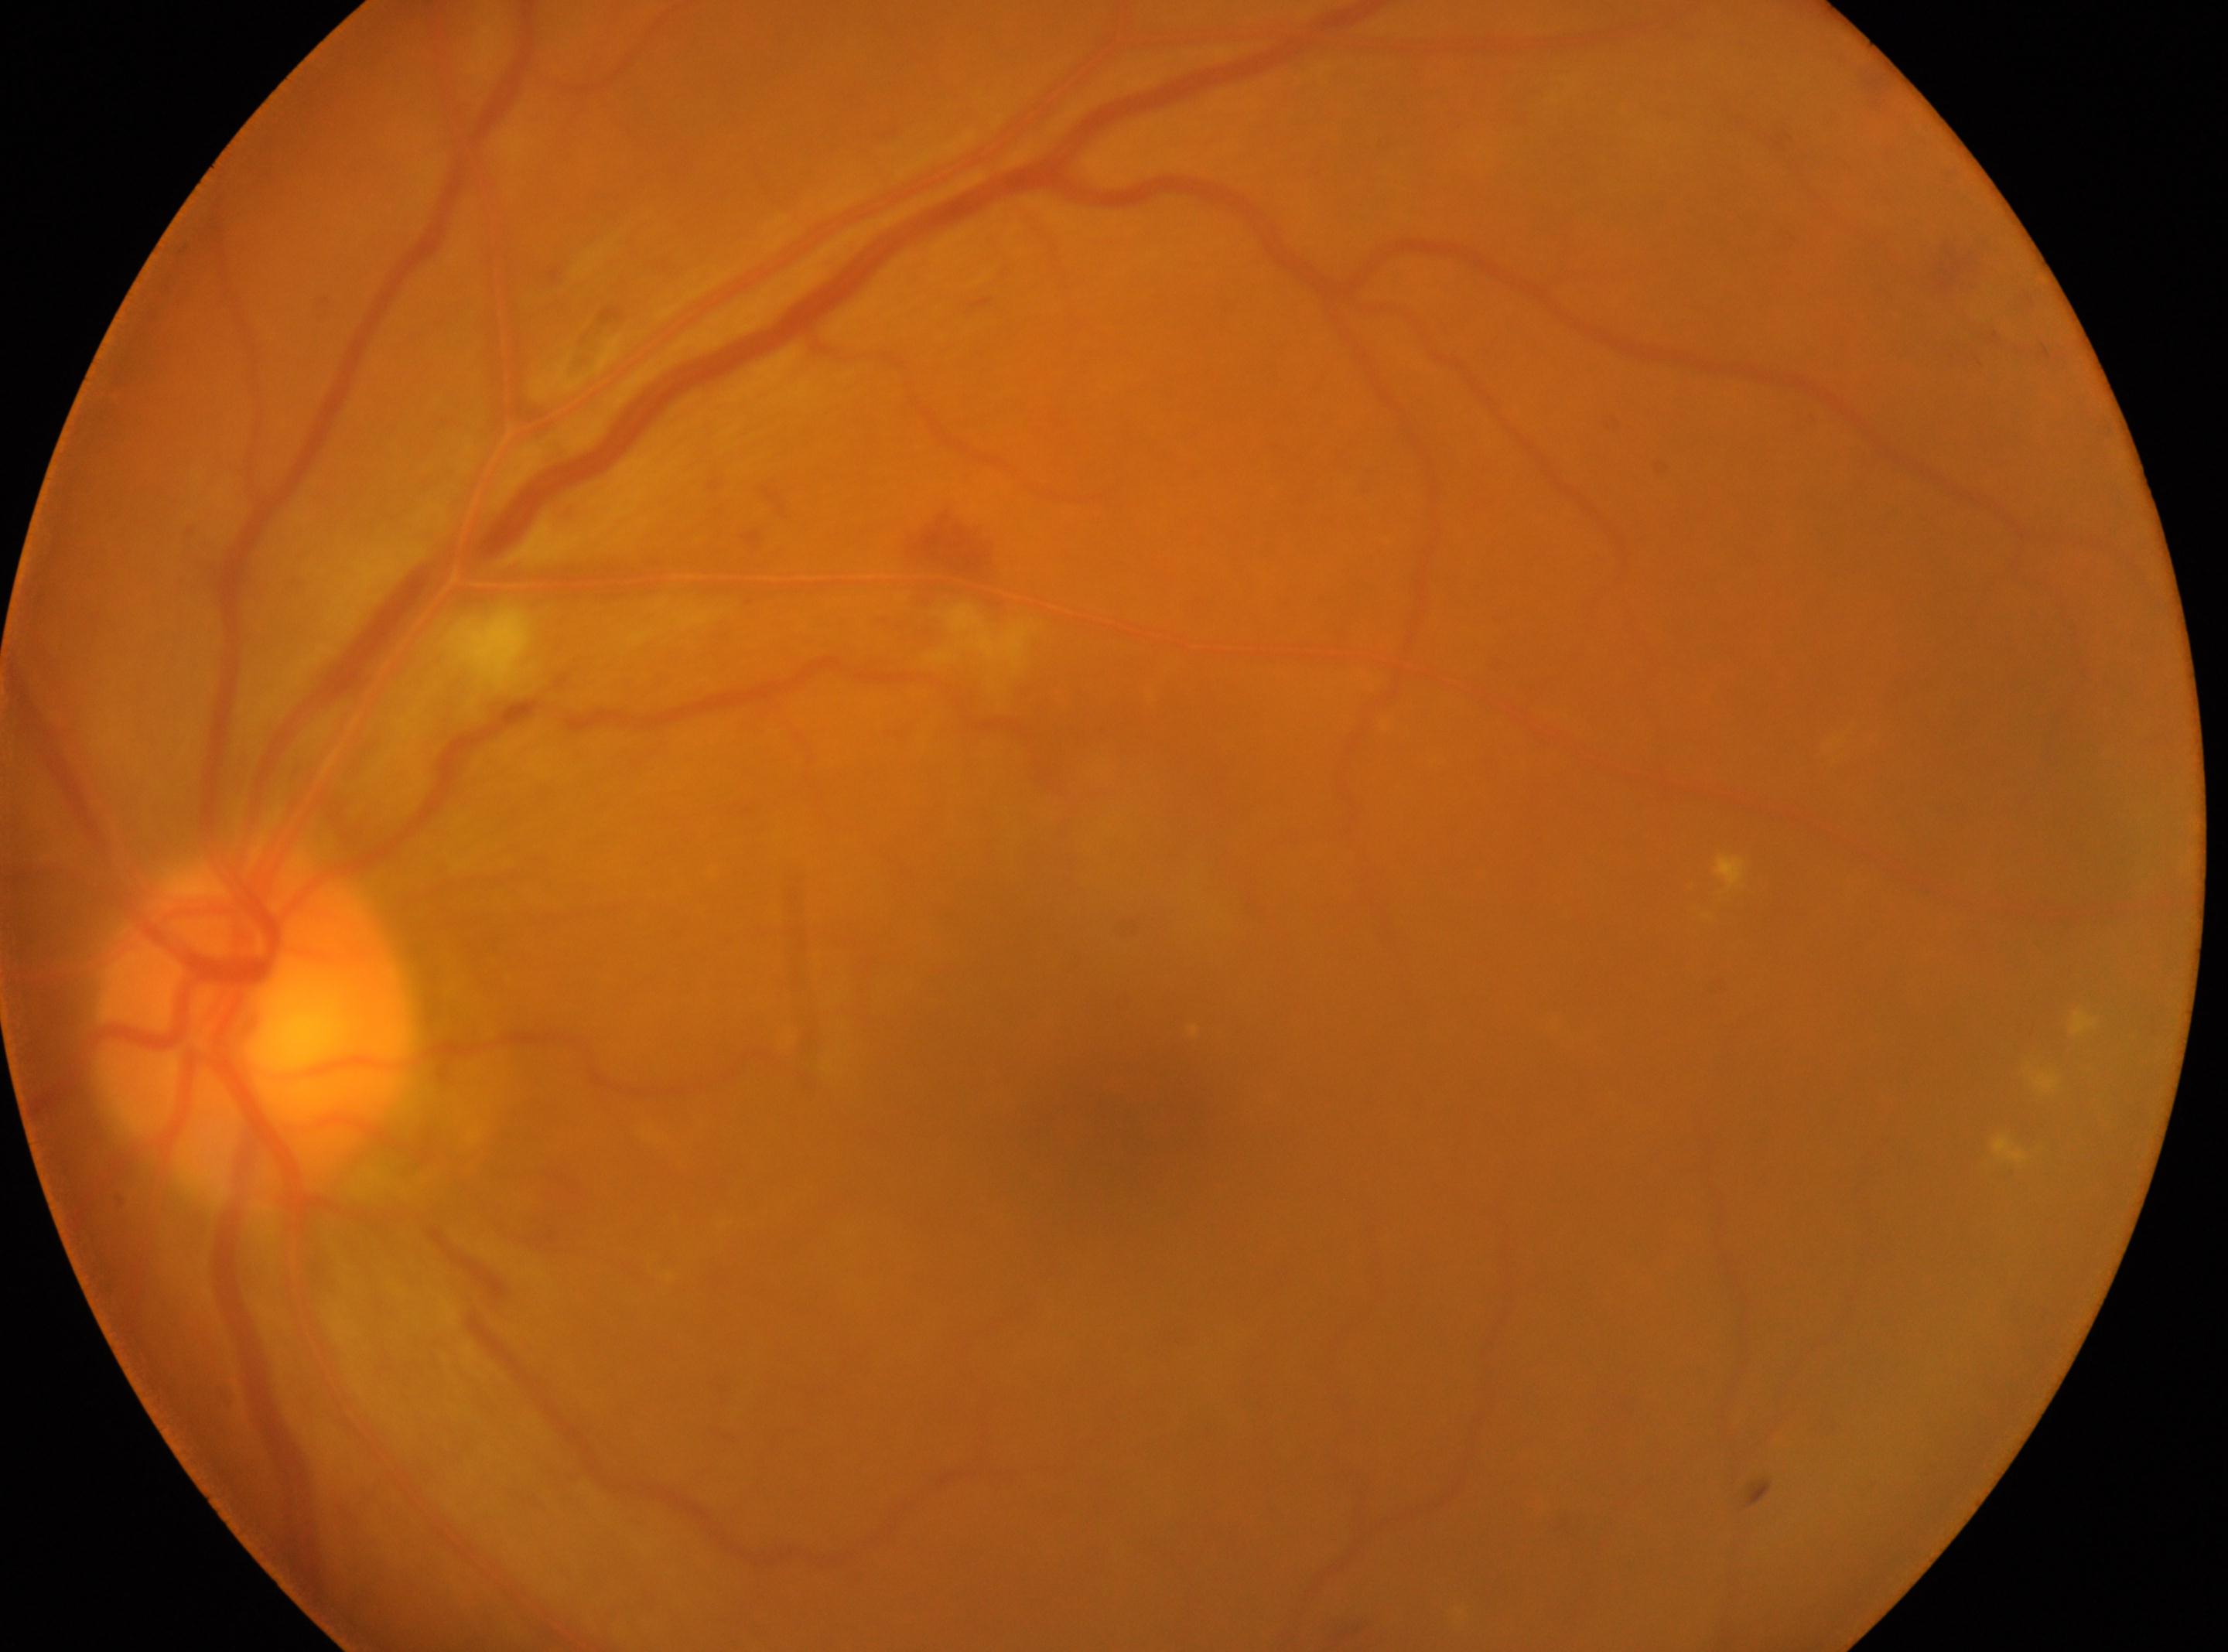 * diabetic retinopathy (DR) · grade 2 (moderate NPDR)
* macular center · (1123, 1118)
* eye · OS
* ONH · (251, 1024)